Diabetic retinopathy graded by the modified Davis classification — 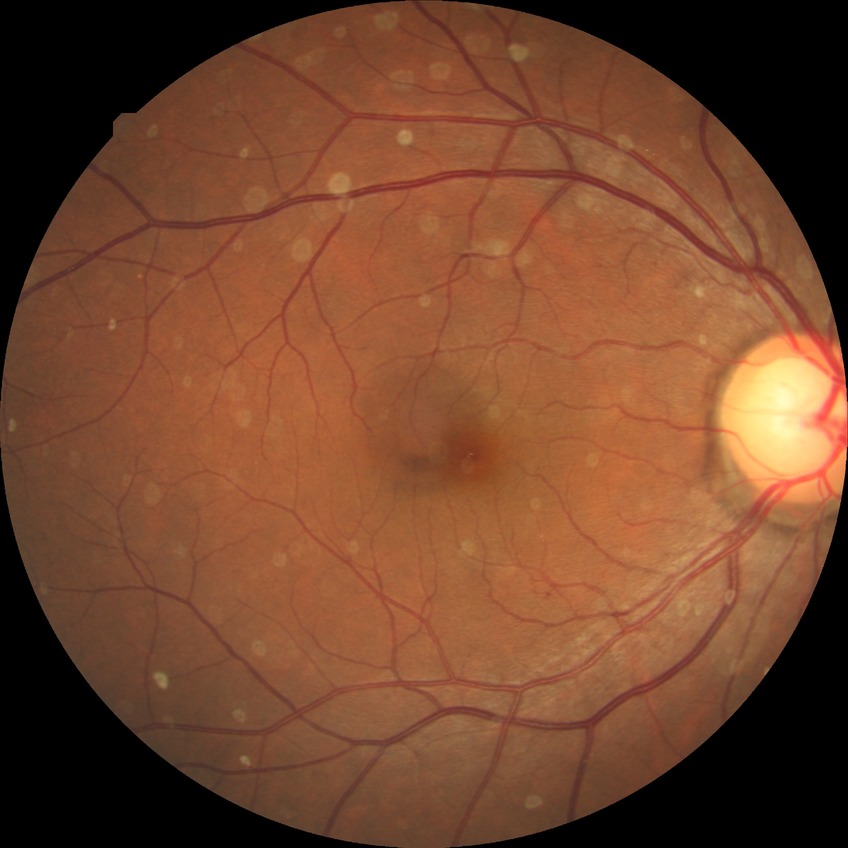 Diabetic retinopathy grade: pre-proliferative diabetic retinopathy.